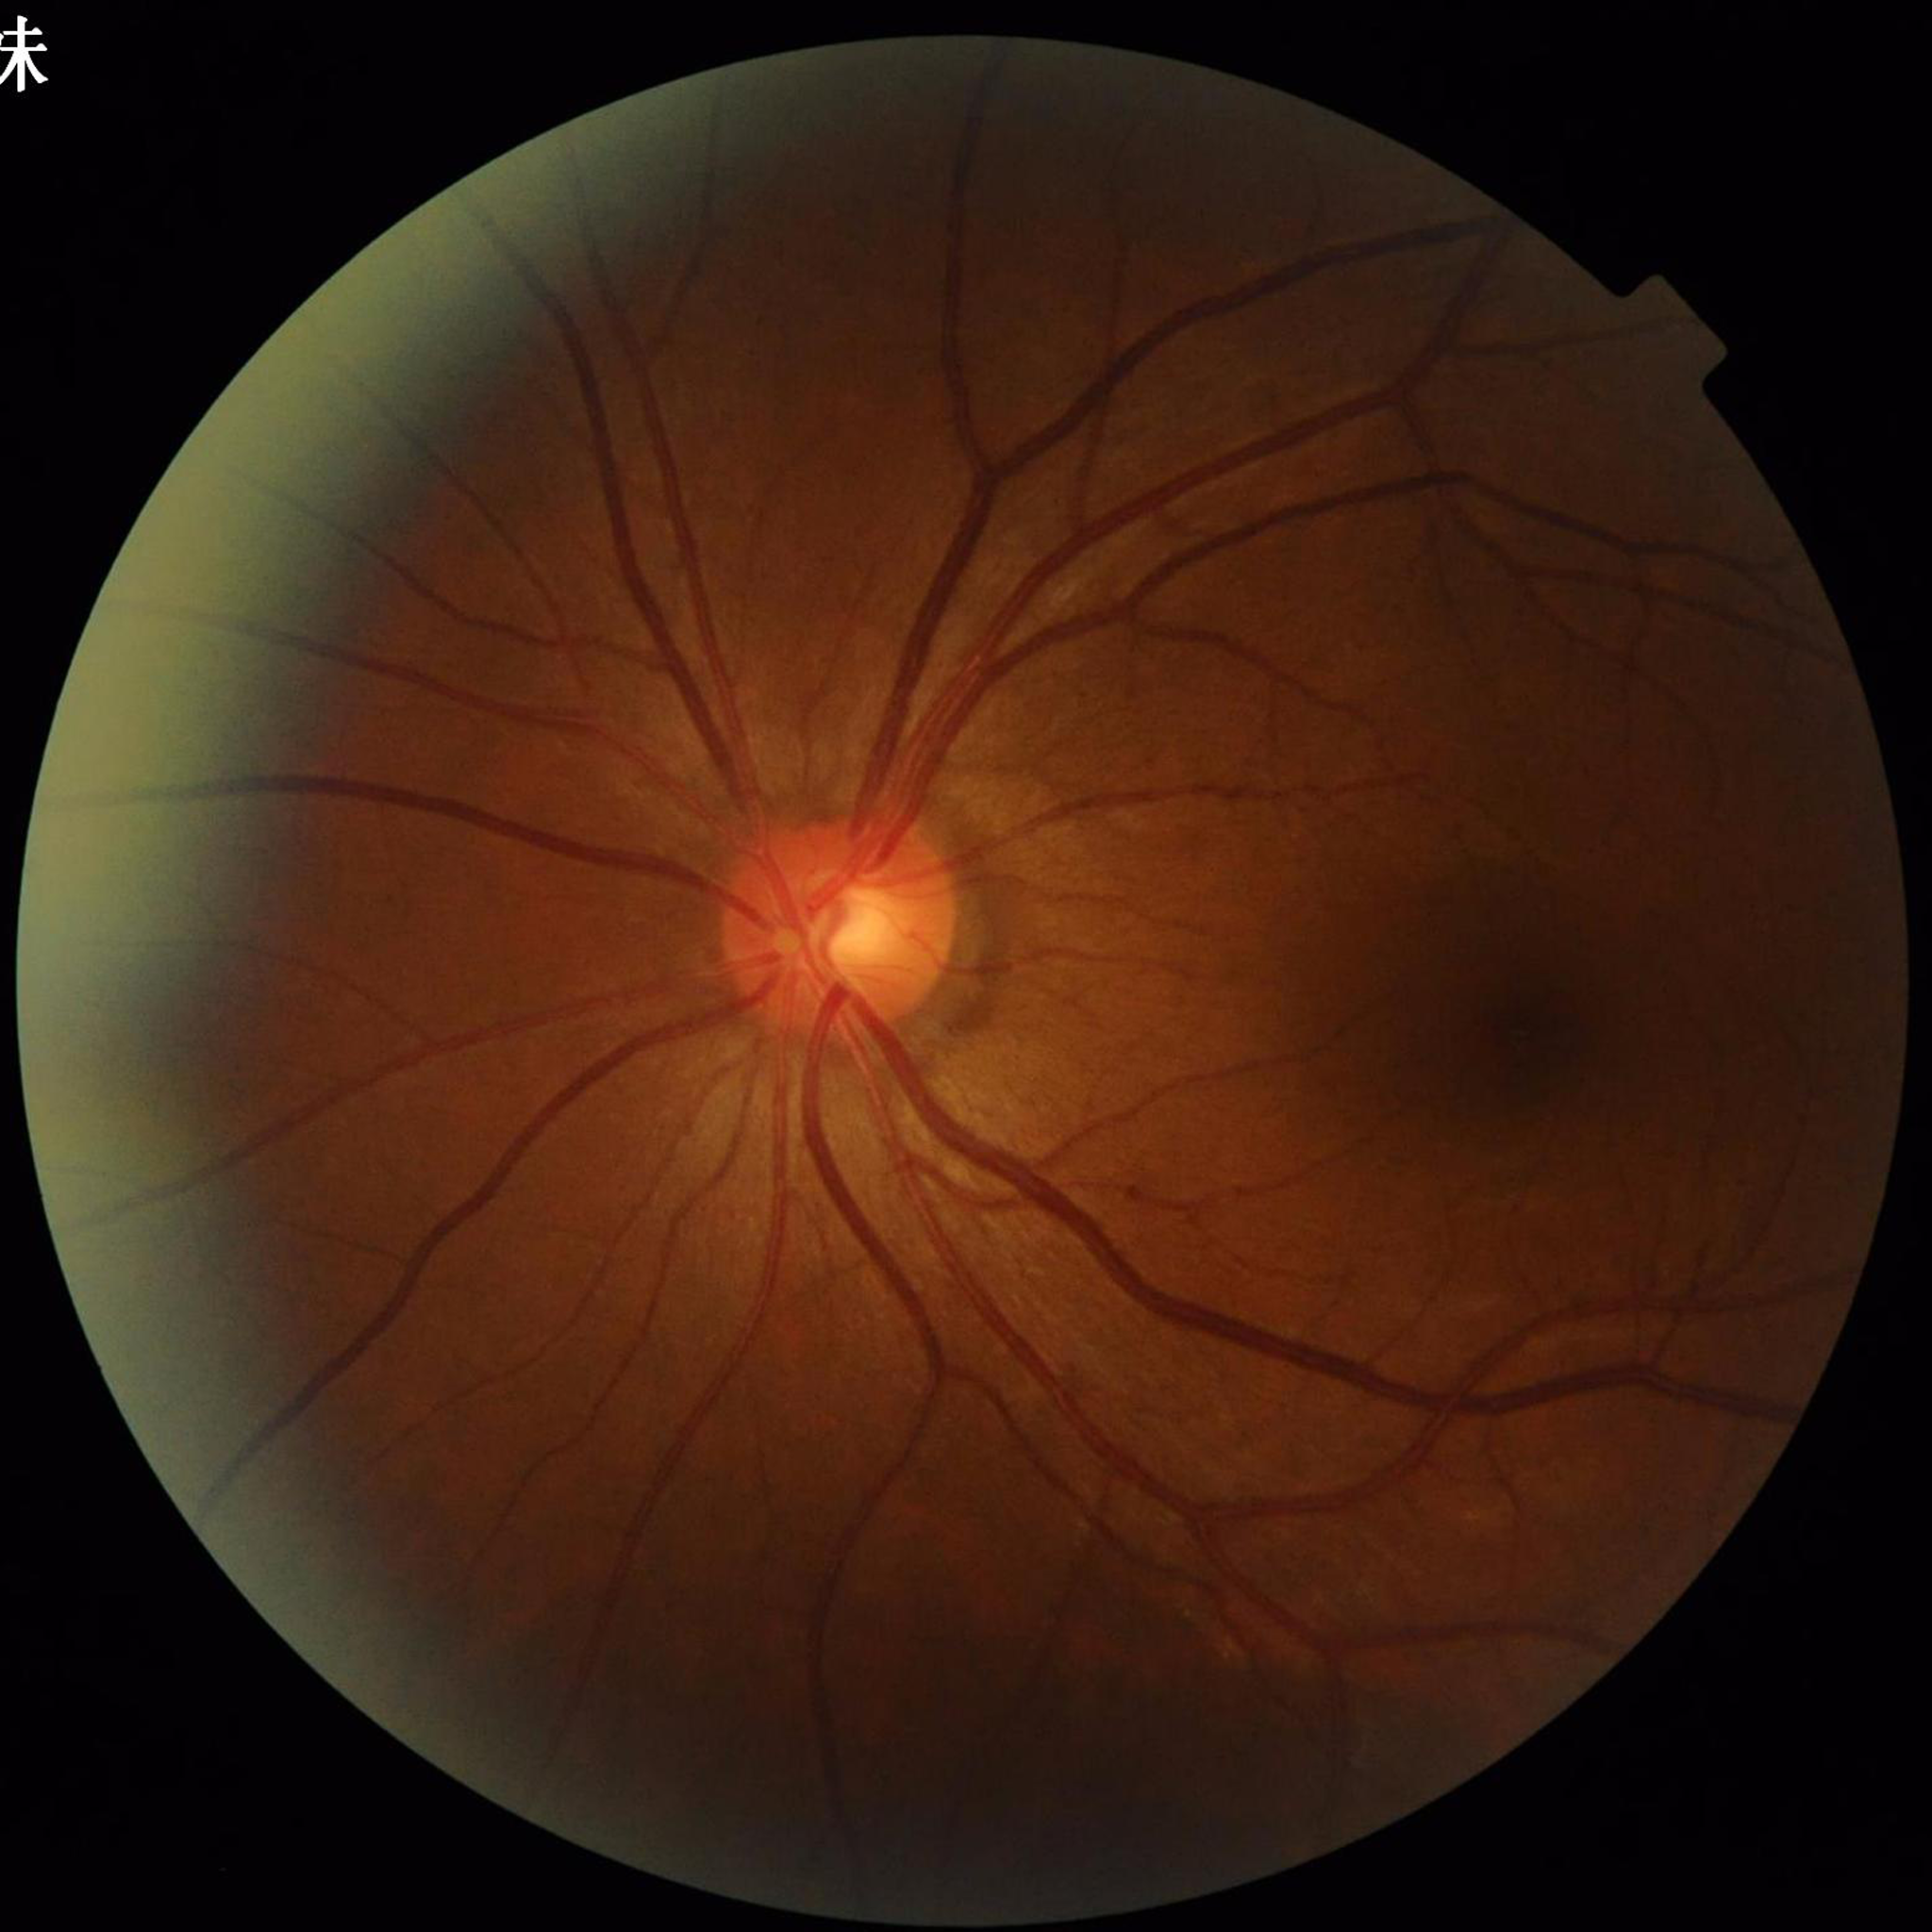 Disease class: glaucoma.